Modified Davis grading. 45 degree fundus photograph. NIDEK AFC-230 fundus camera. Nonmydriatic fundus photograph: 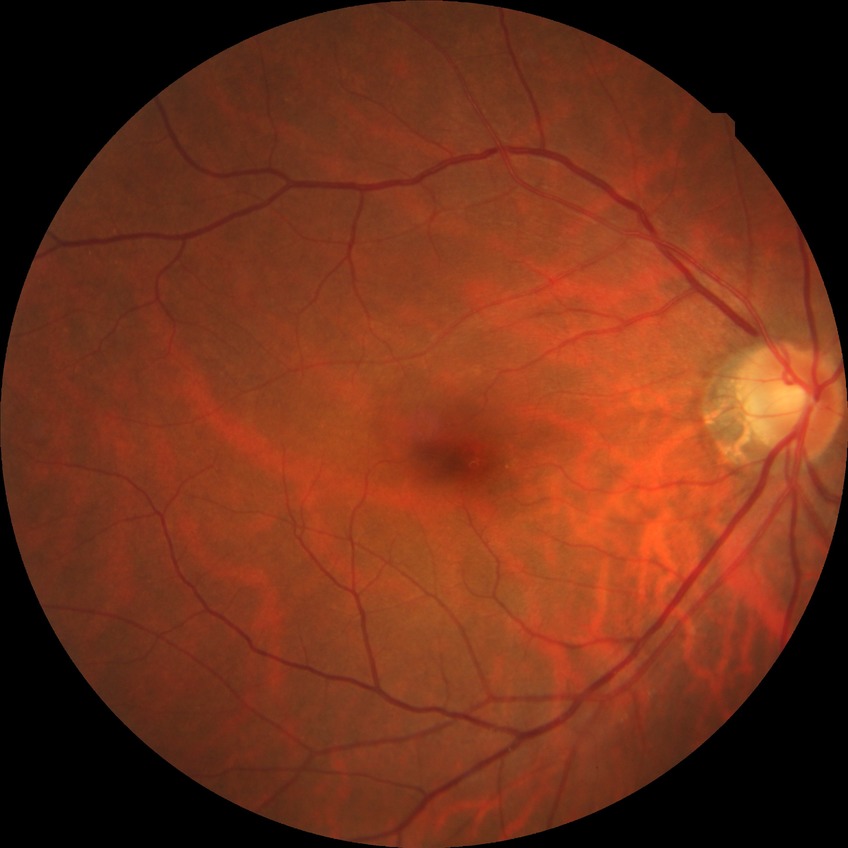
Annotations:
* diabetic retinopathy (DR) — NDR (no diabetic retinopathy)